100° field of view (Phoenix ICON) · Phoenix ICON wide-field infant fundus image
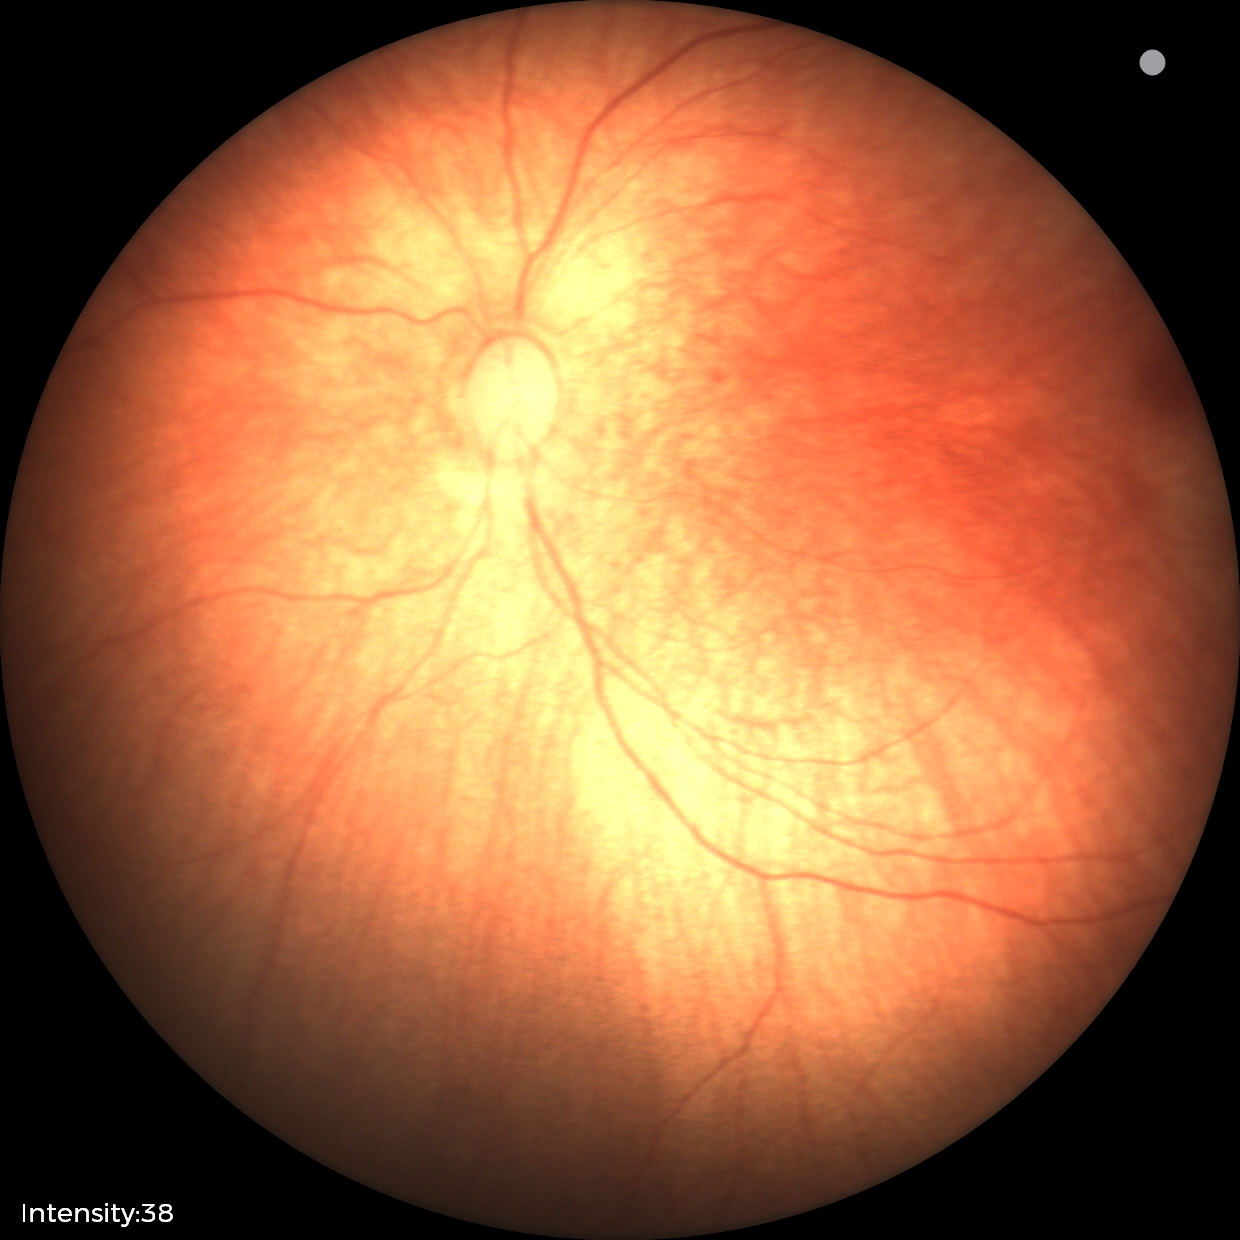
Screening examination diagnosed as physiological.